Nonmydriatic fundus photograph. Camera: NIDEK AFC-230 — 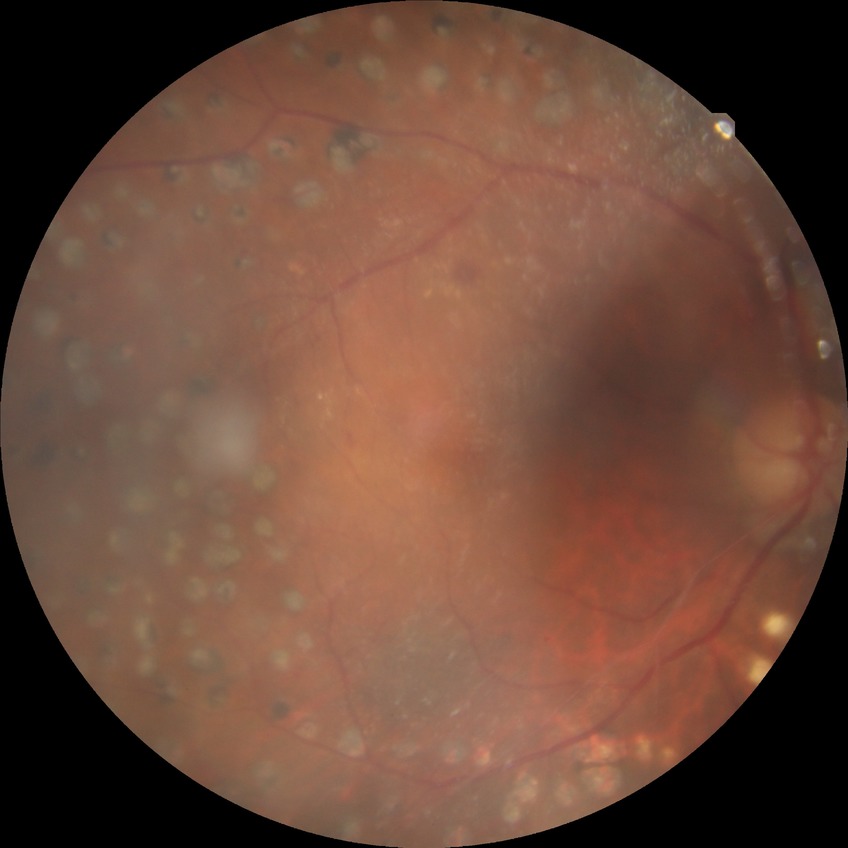 Findings:
* diabetic retinopathy (DR): proliferative diabetic retinopathy (PDR)